CFP: 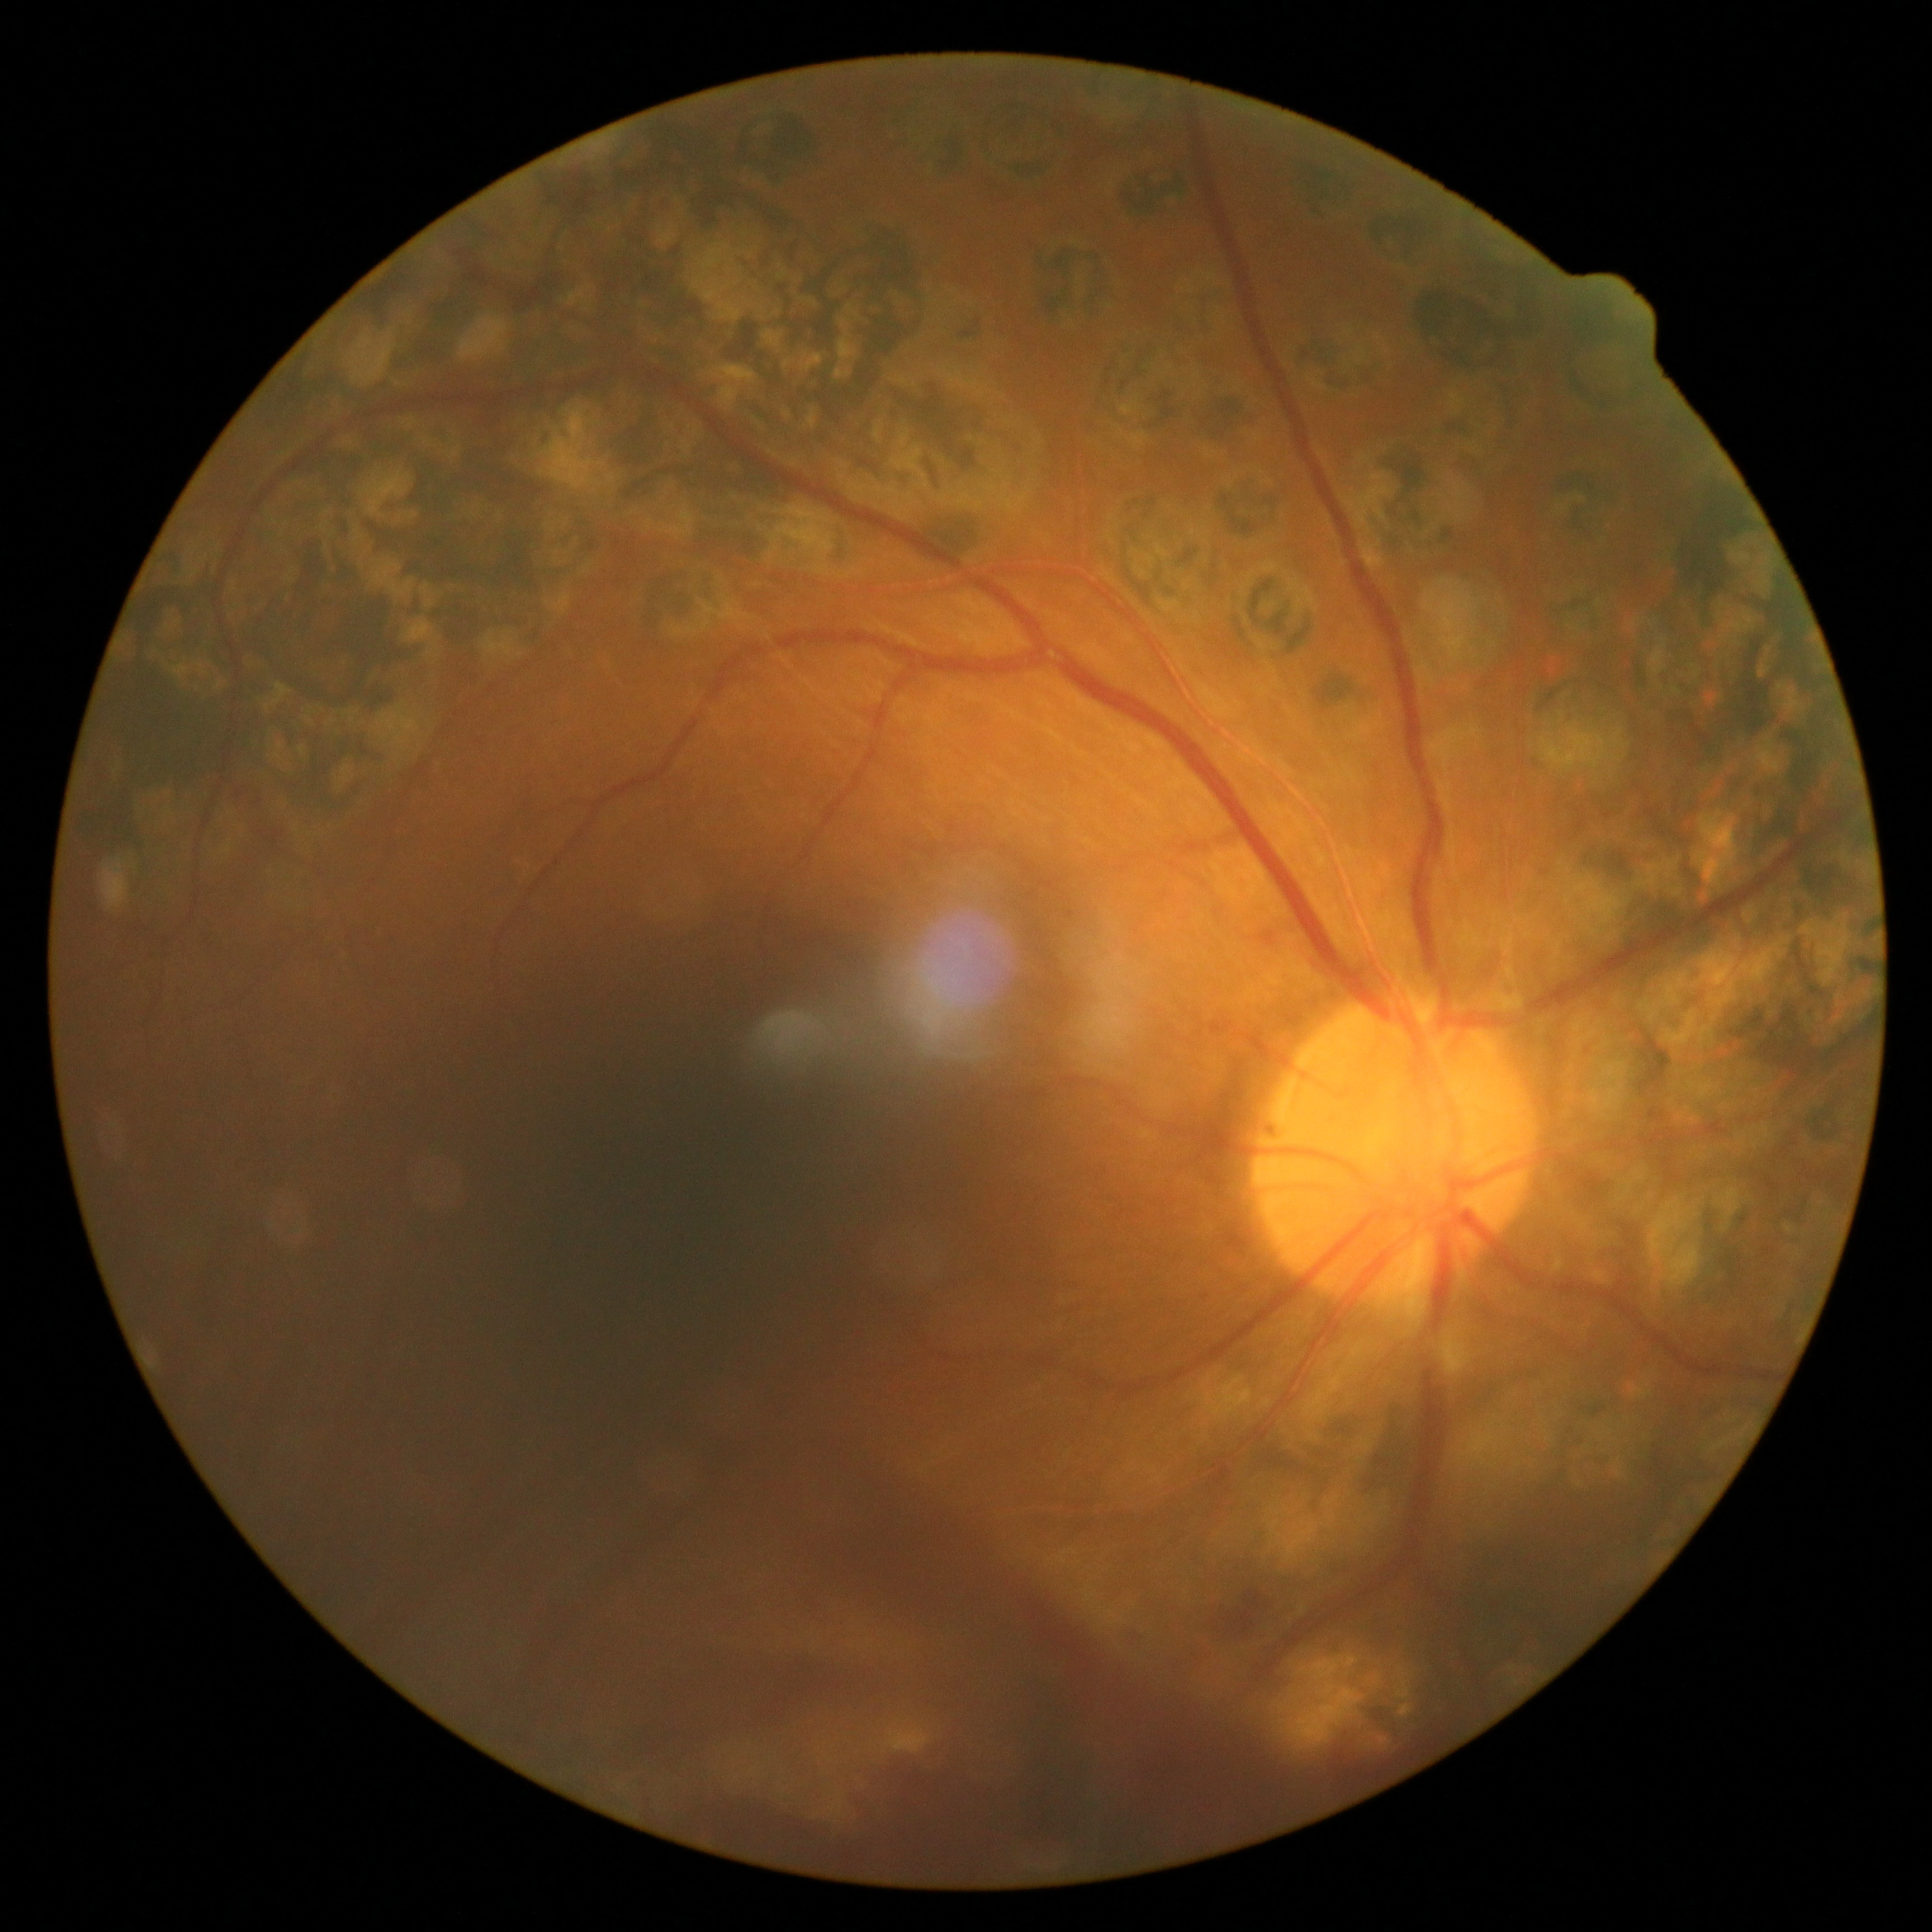
DR is PDR (grade 4).